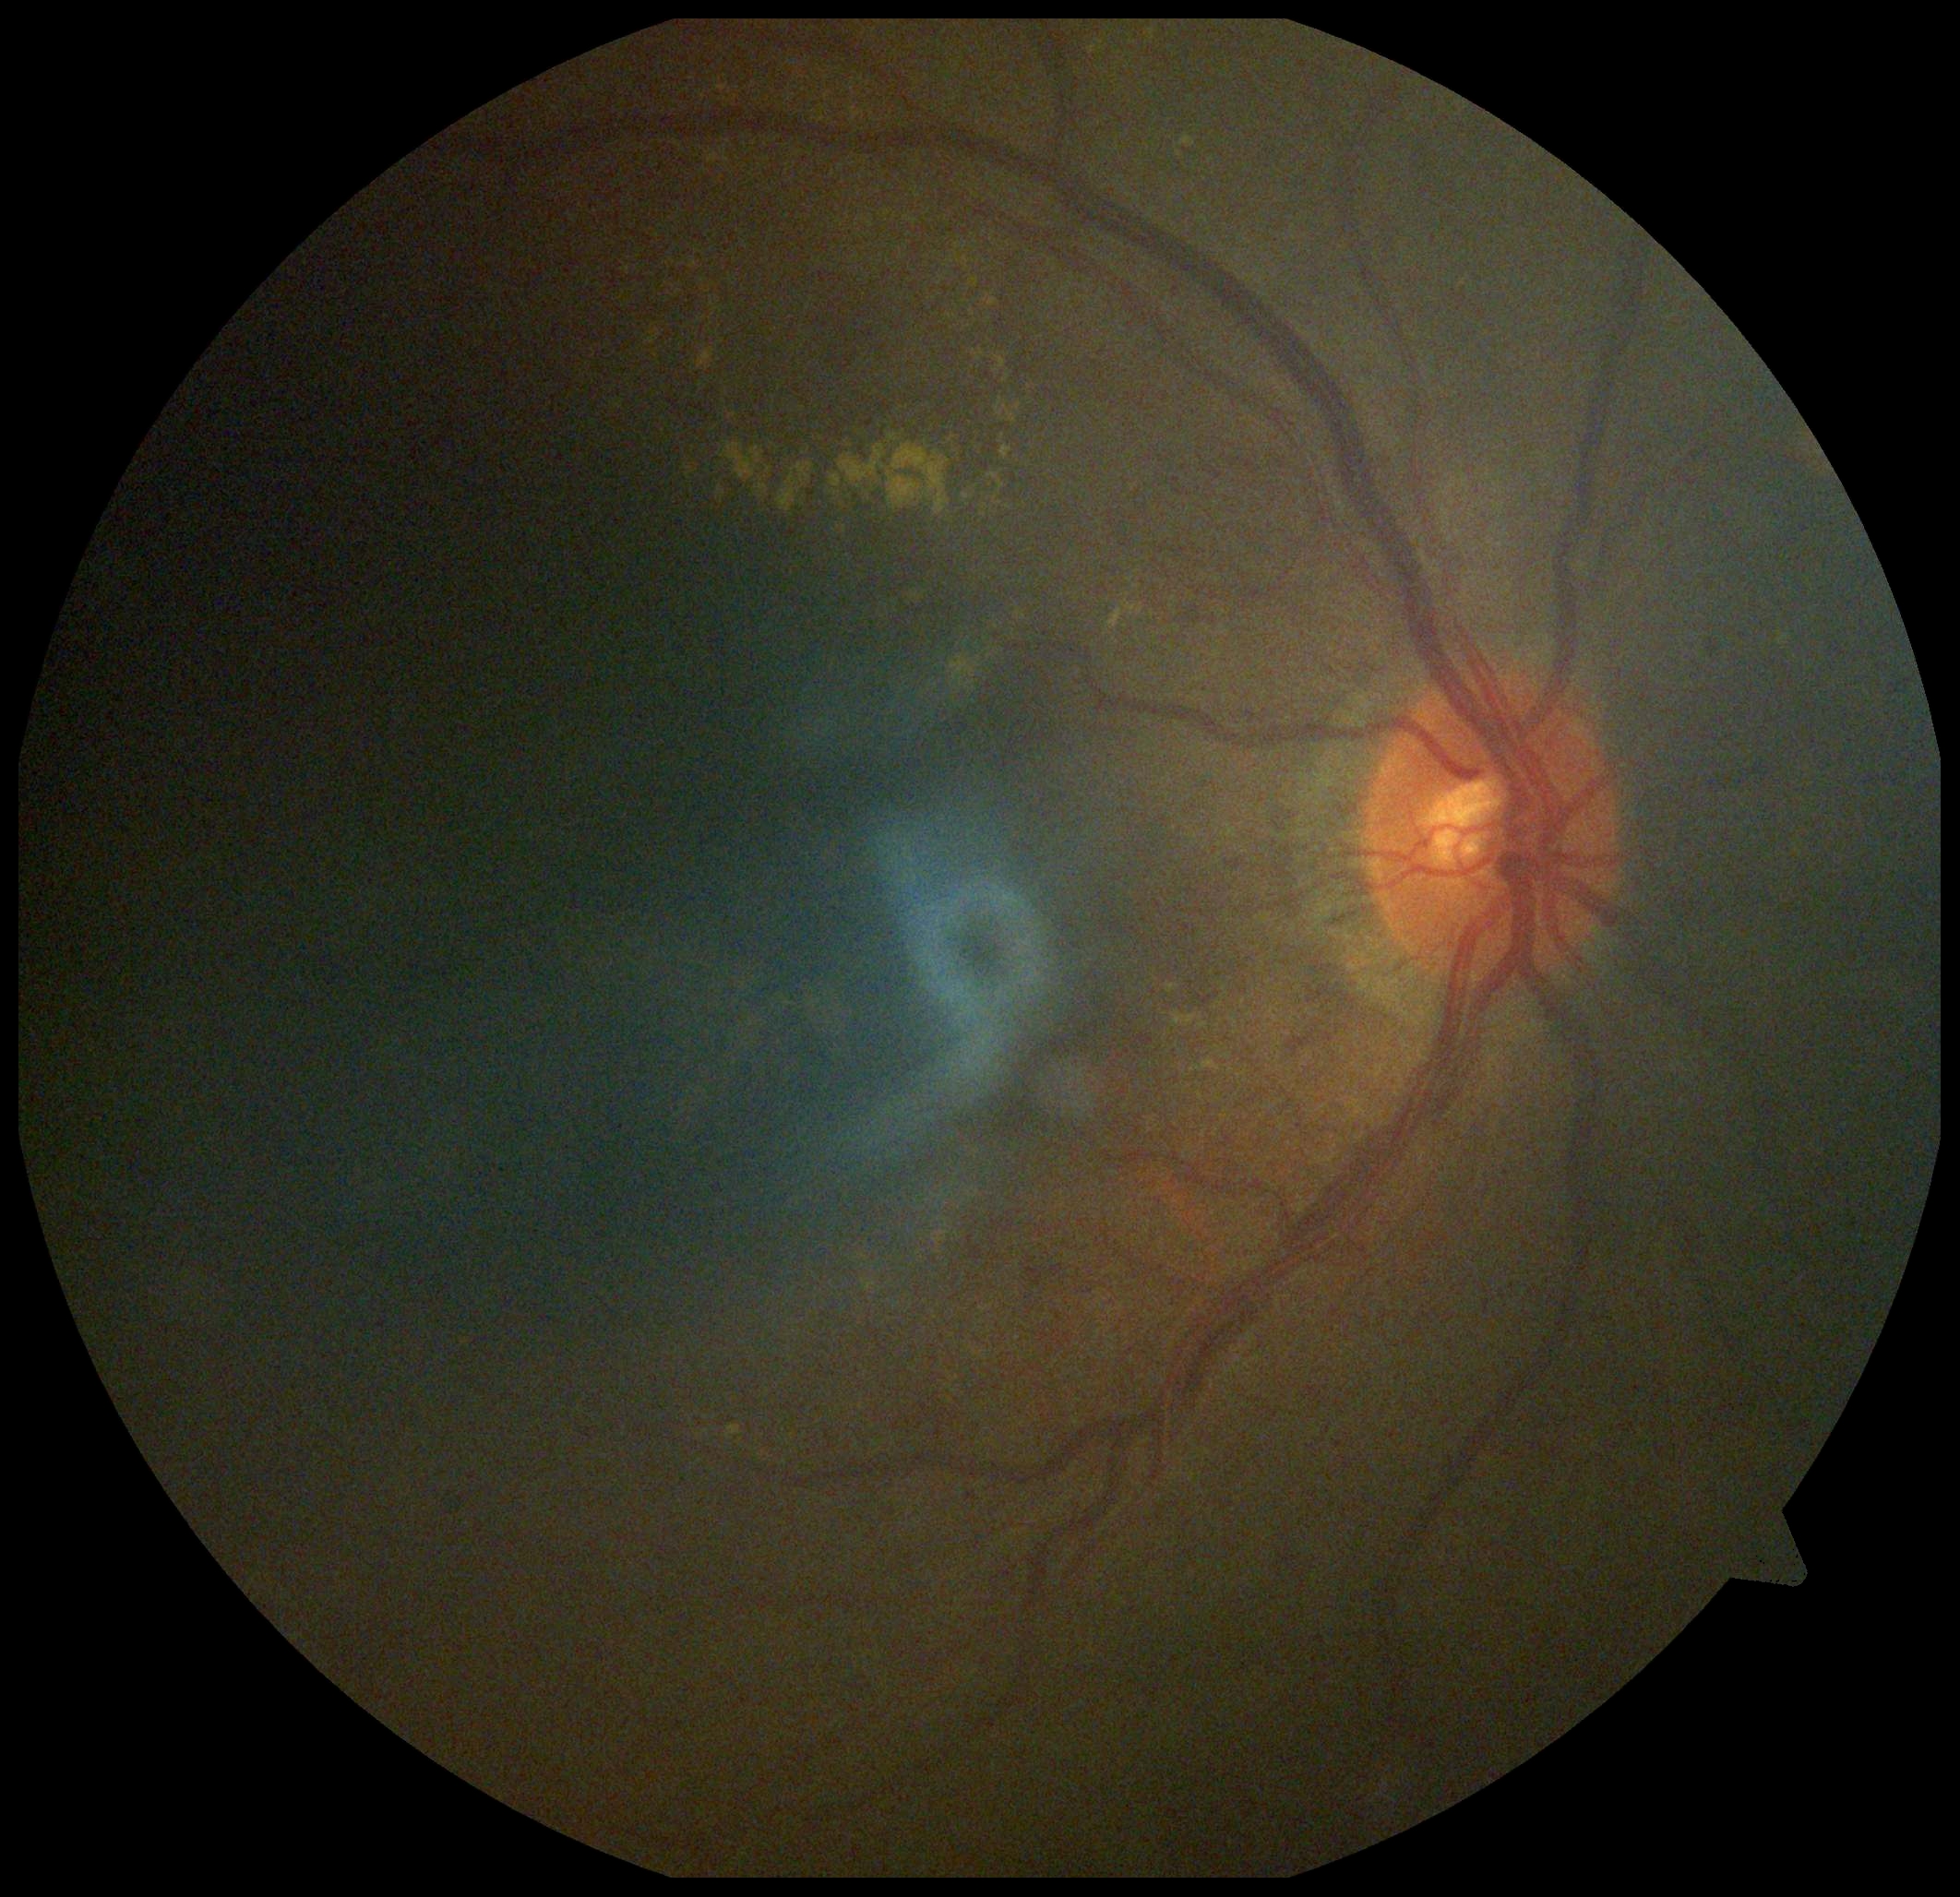

  dr_grade: moderate NPDR (grade 2) — more than just microaneurysms but less than severe NPDR